Fundus photo — 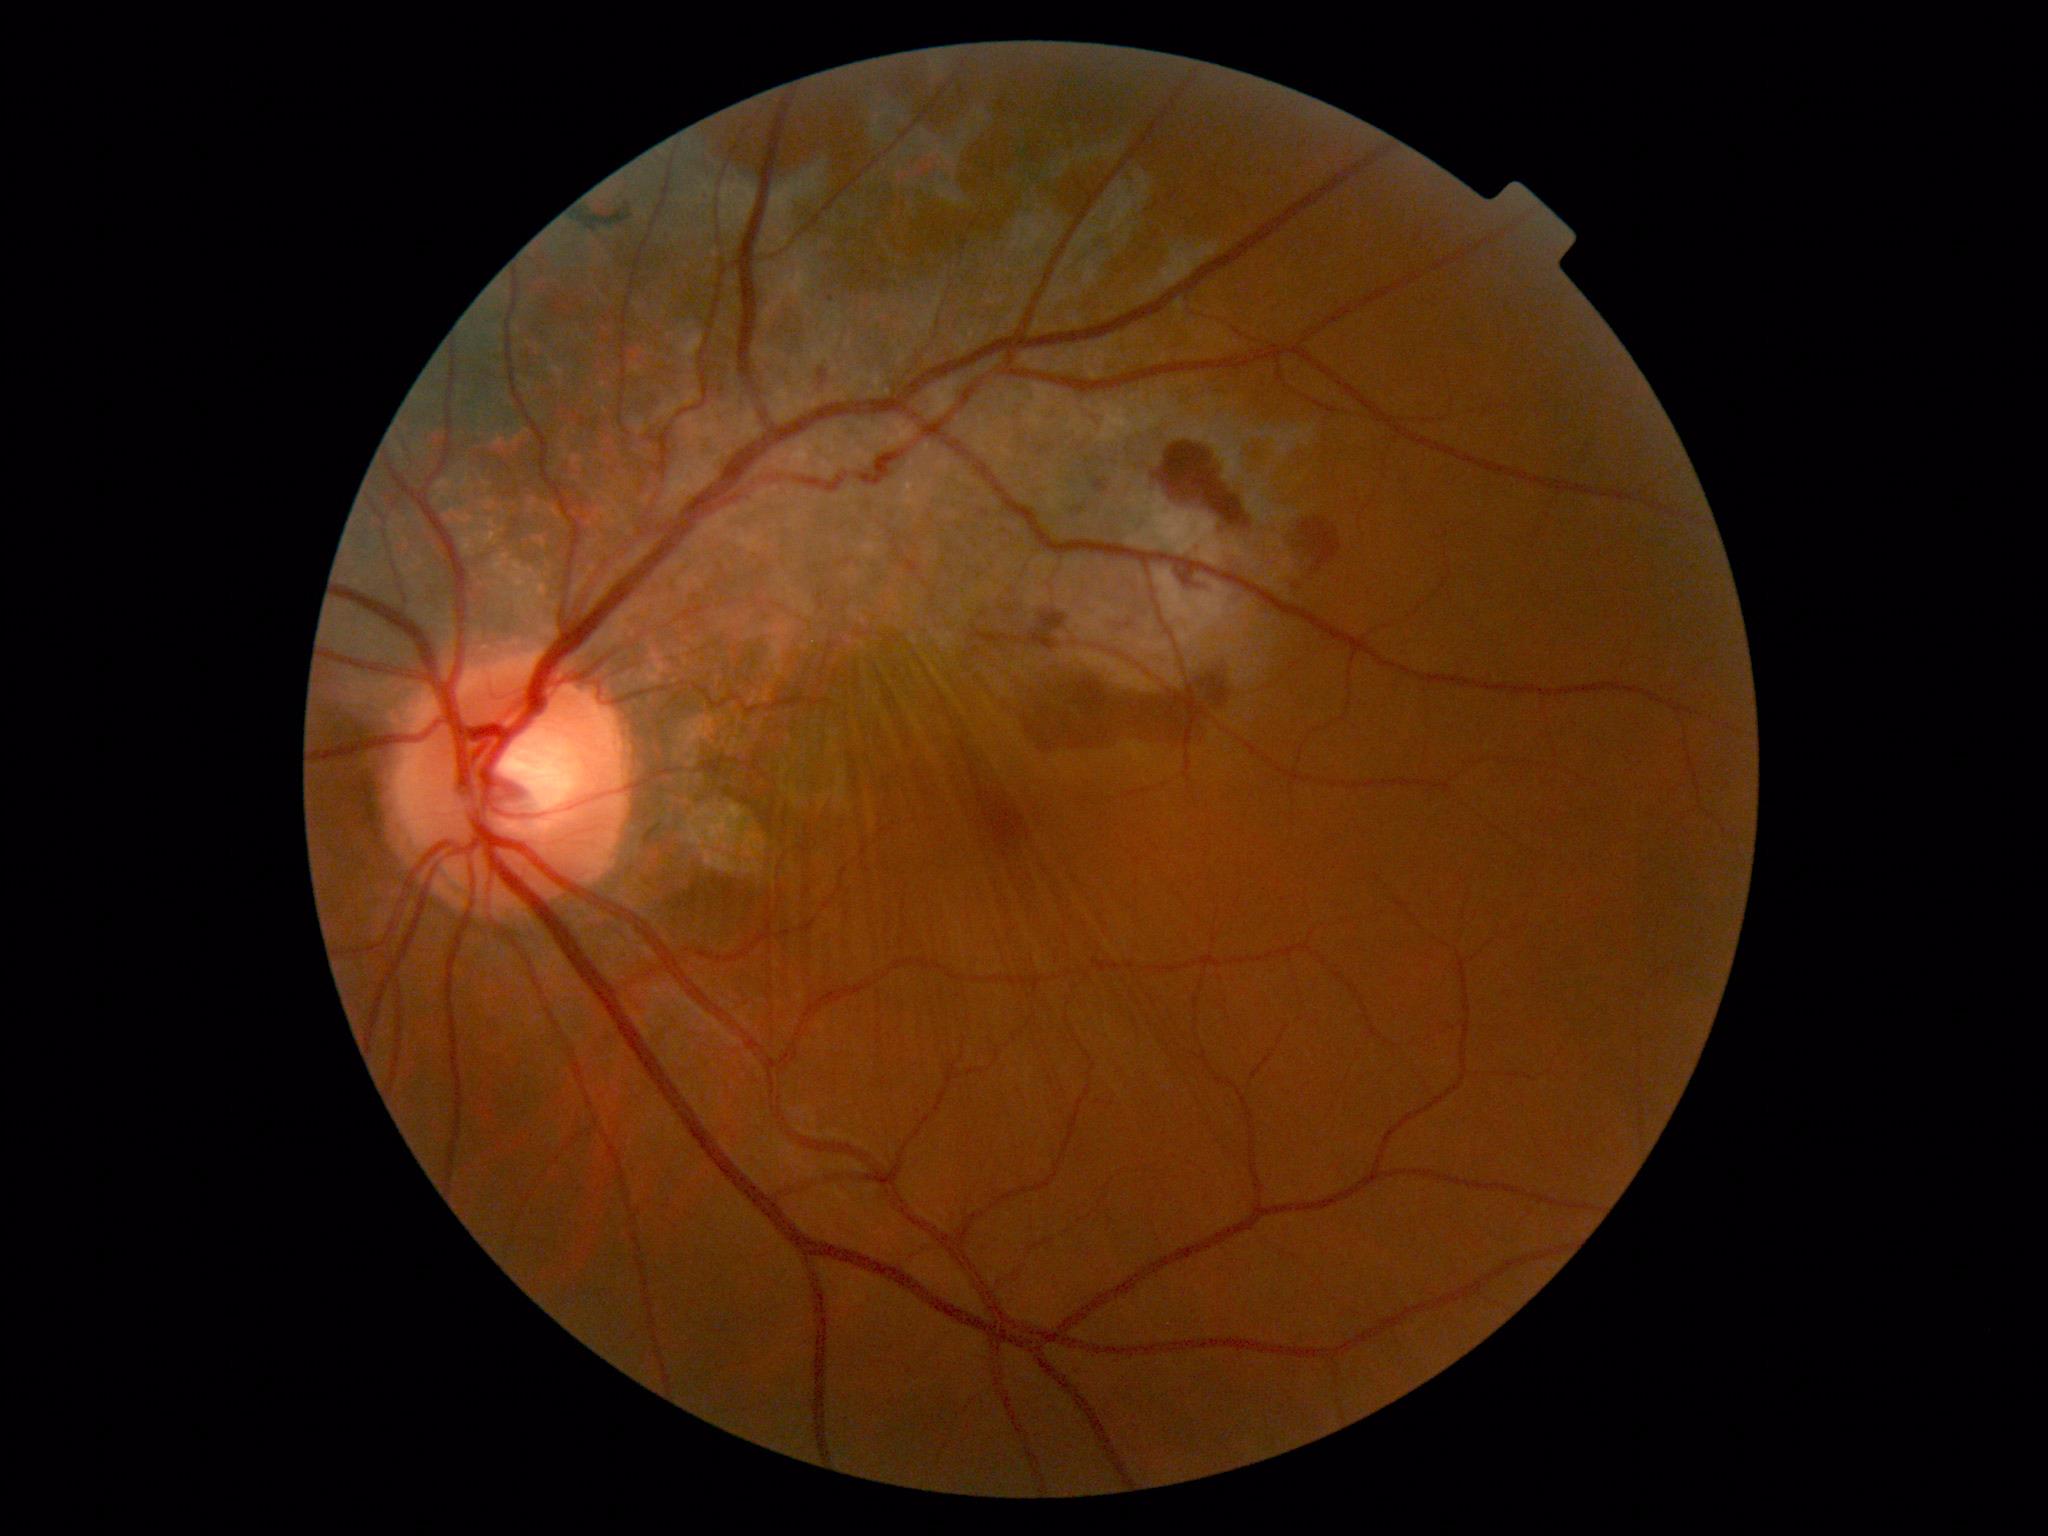
Diabetic retinopathy is grade 4 (PDR) — neovascularization and/or vitreous/pre-retinal hemorrhage.